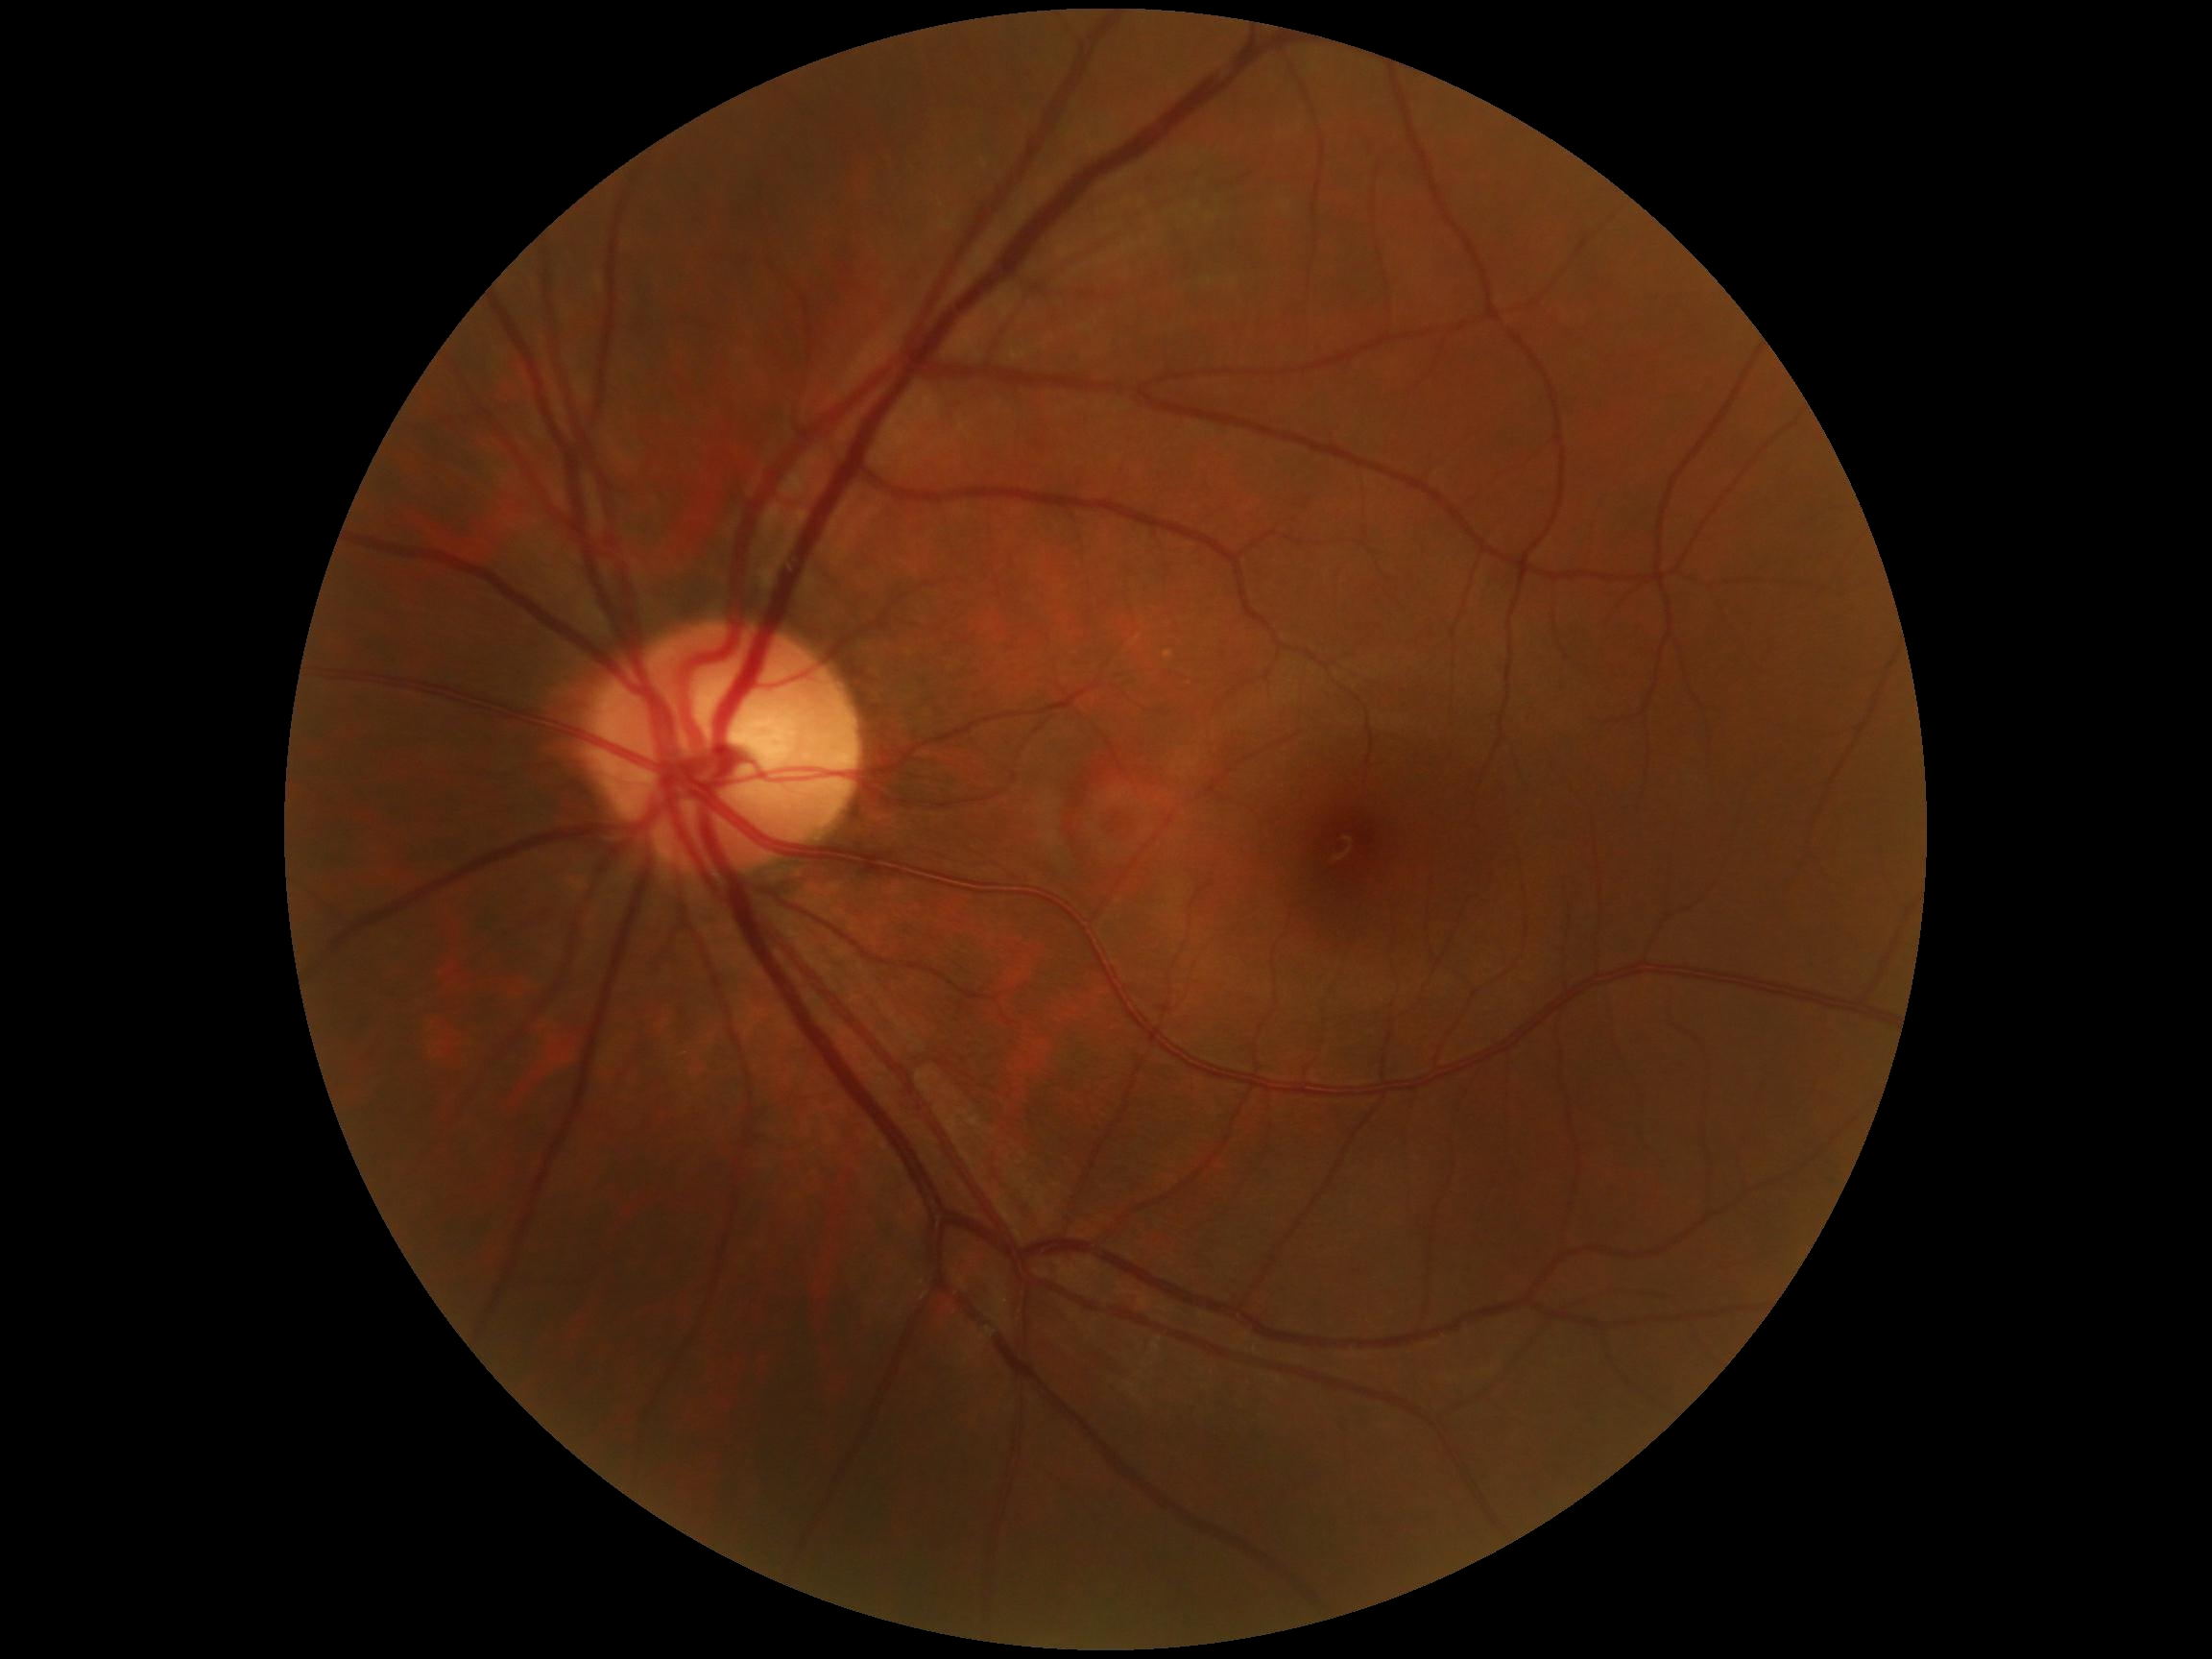 diabetic retinopathy severity: 0/4.